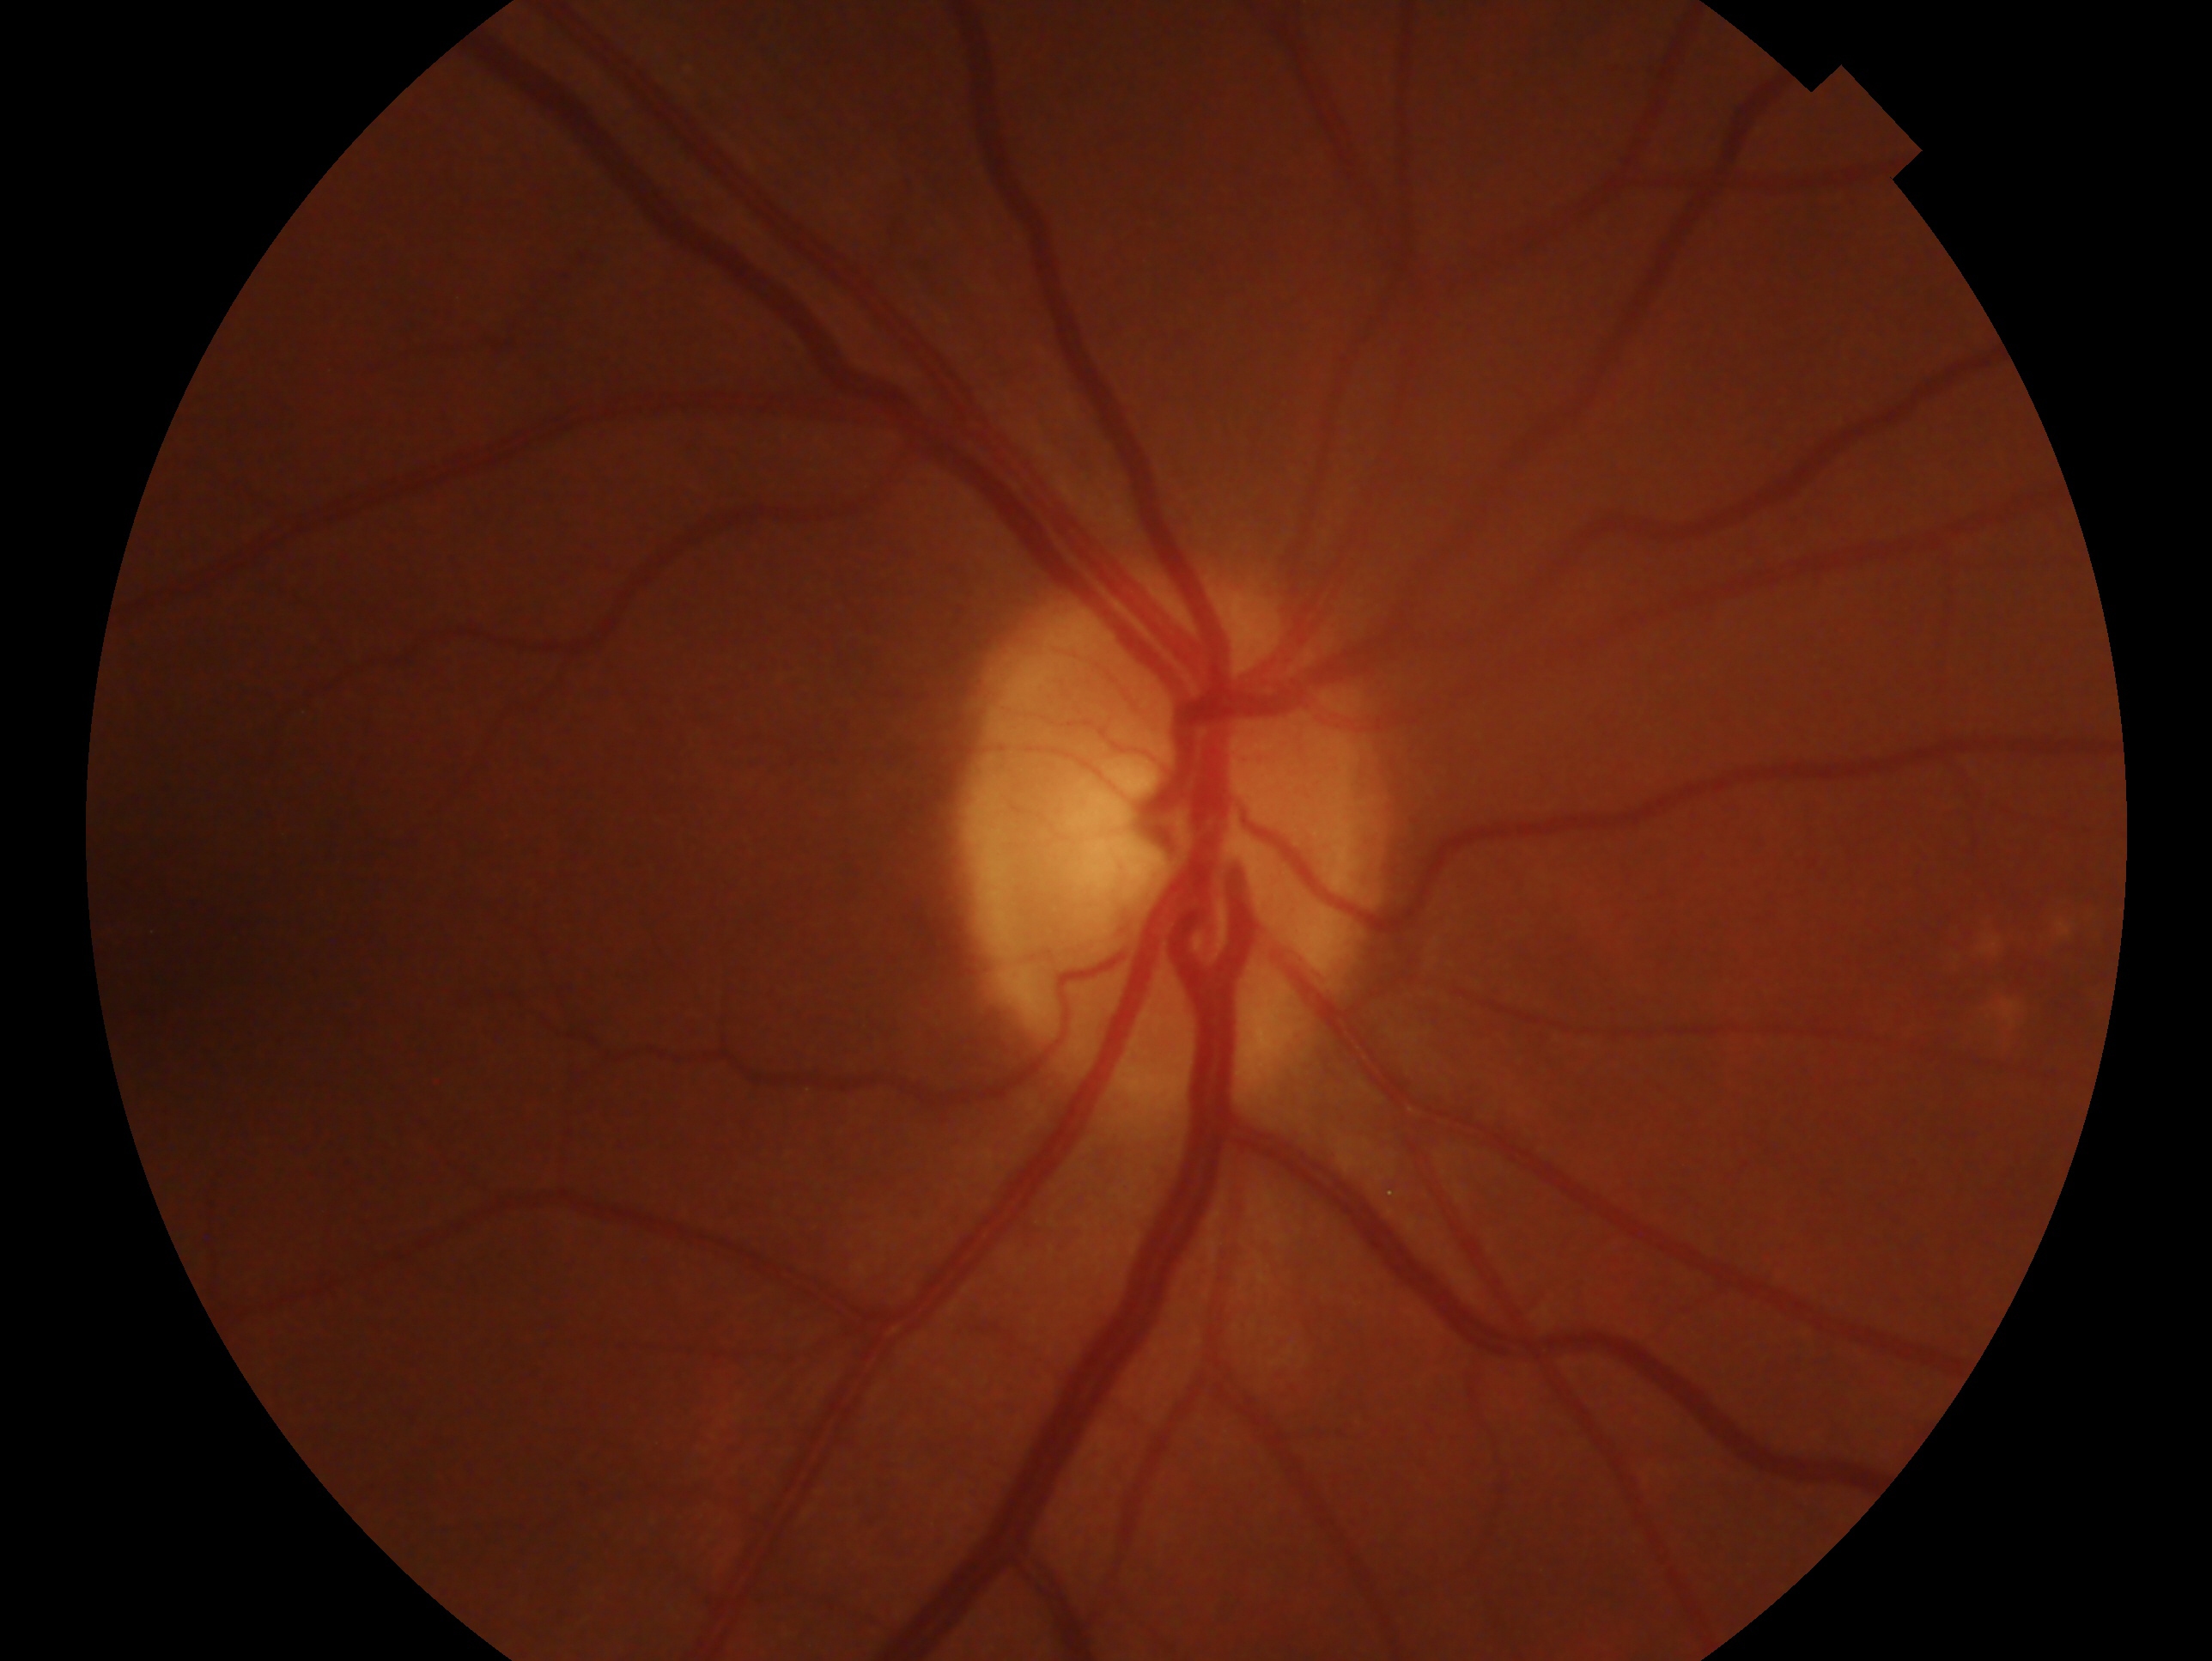

Diagnosis: no signs of glaucoma.
Imaged eye: OD.